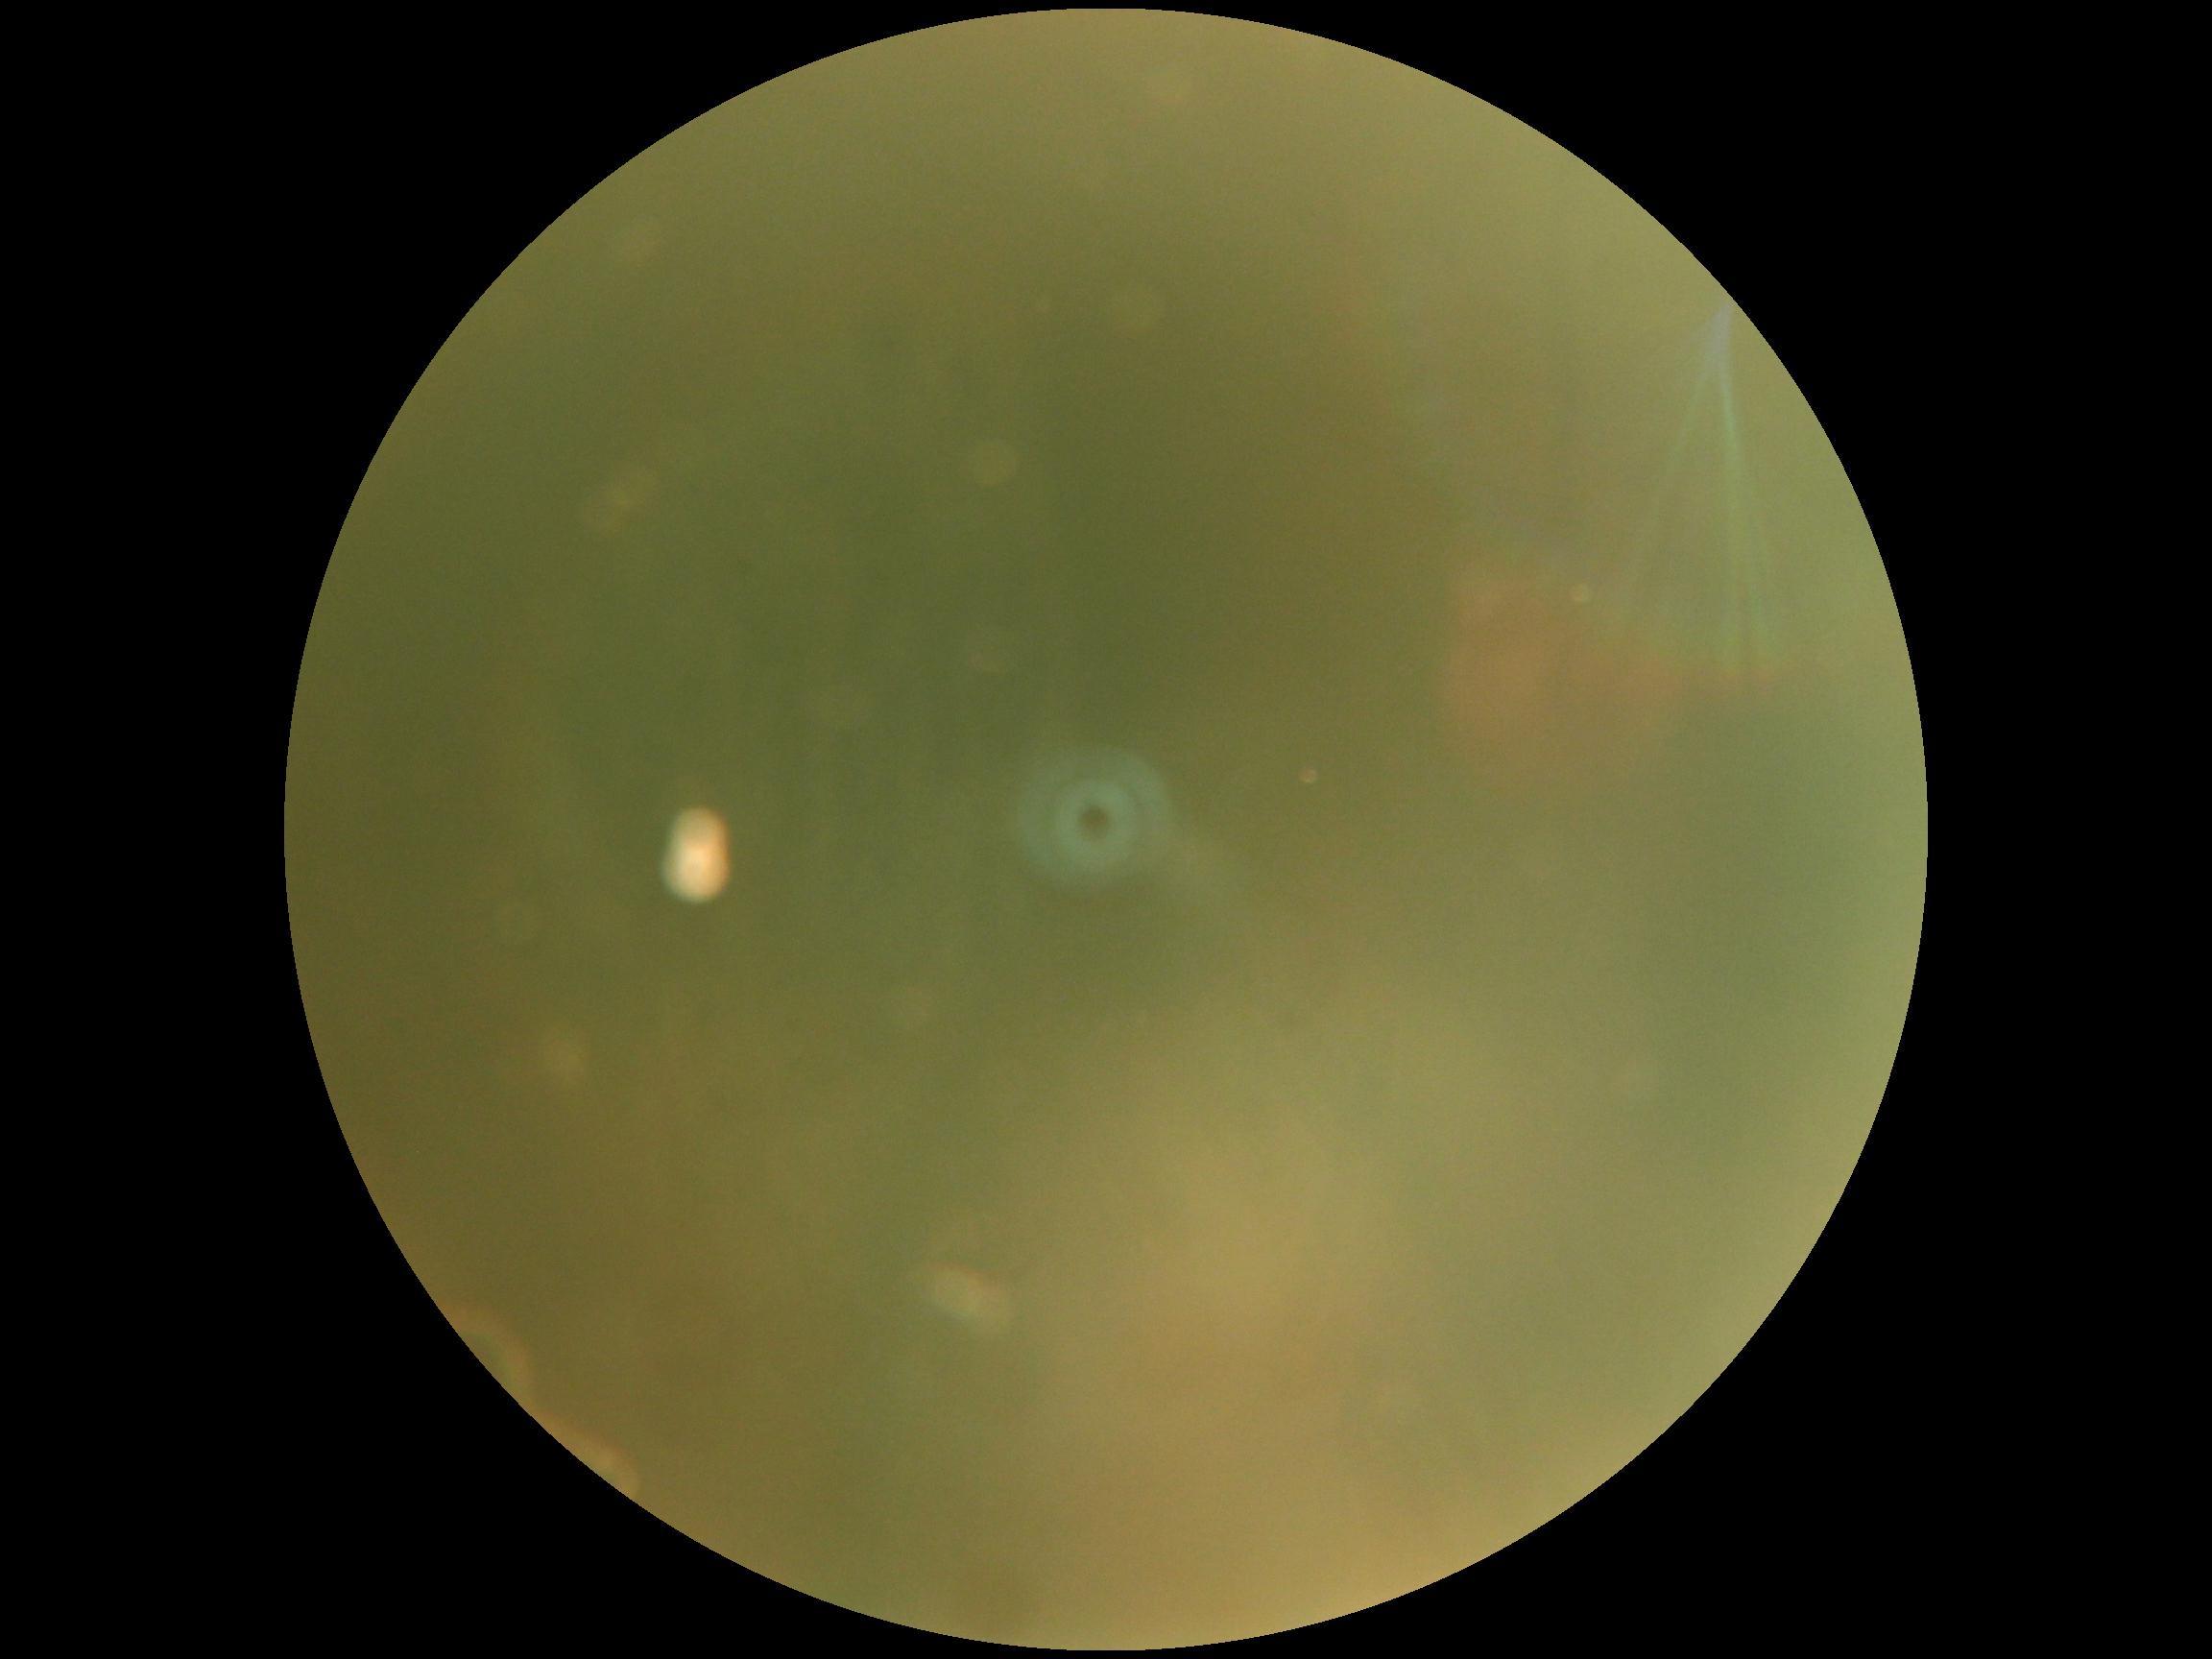

image quality = insufficient; DR severity = ungradable.